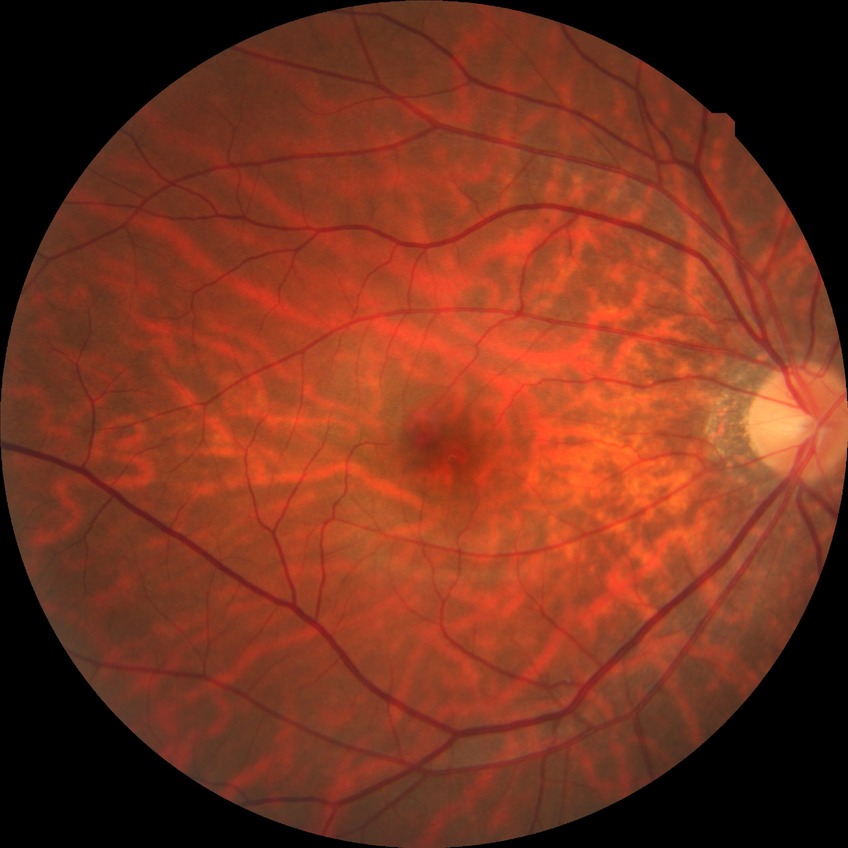
DR stage is NDR.